Phoenix ICON wide-field infant fundus image — 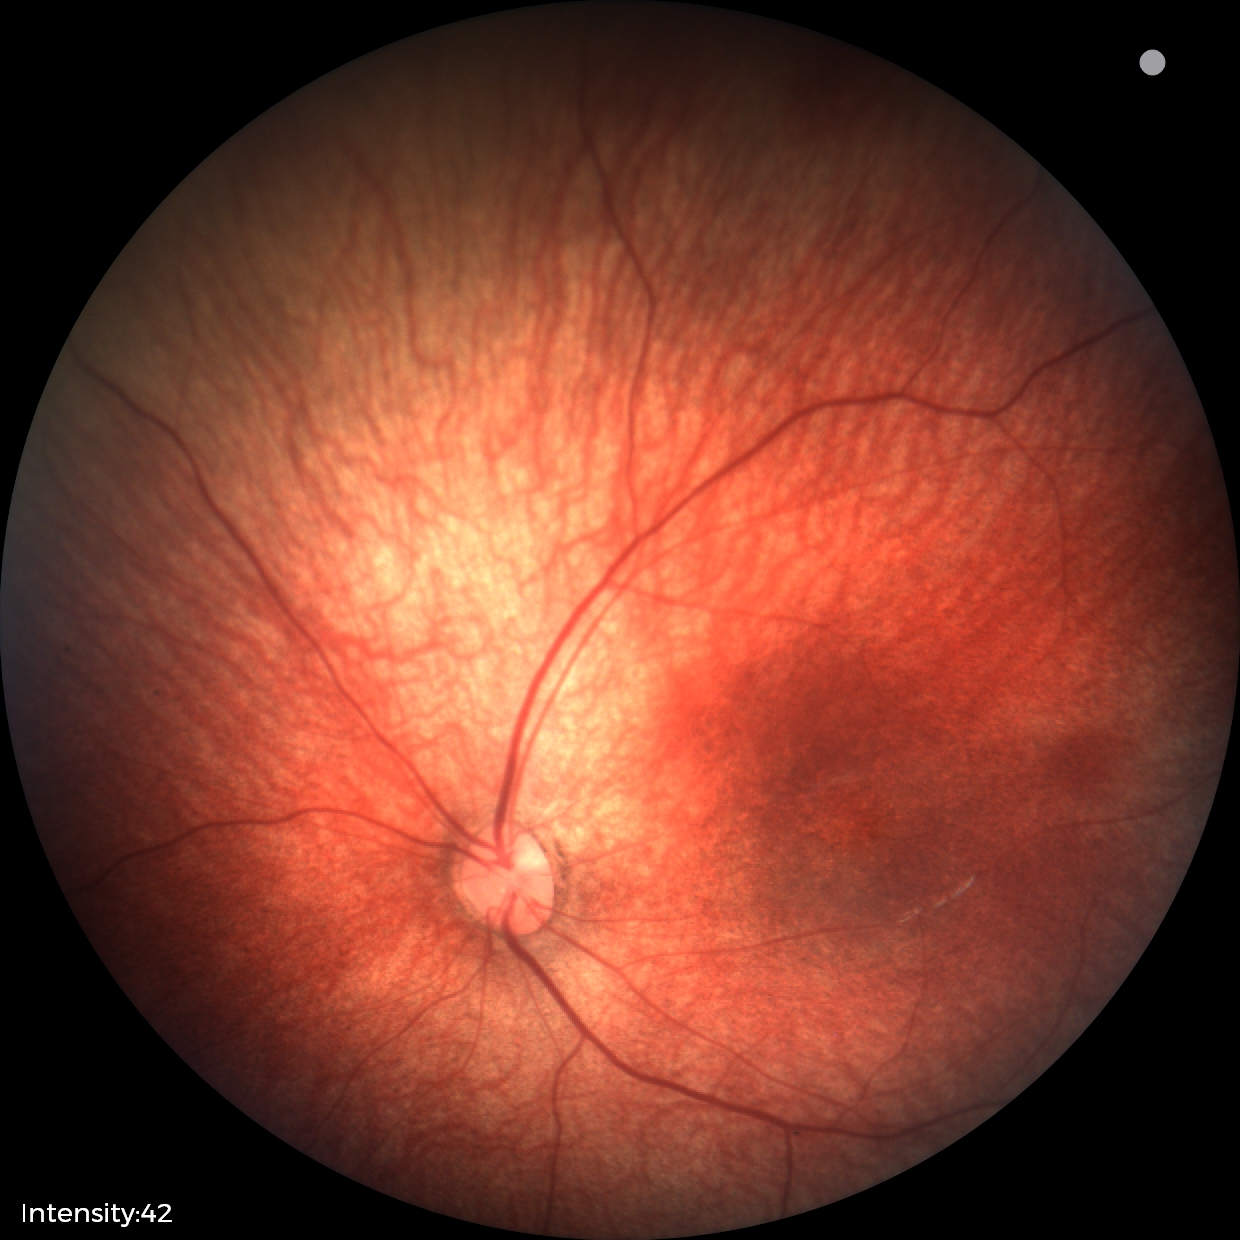
Screening diagnosis: normal retinal appearance.